Color fundus image; image size 2352x1568:
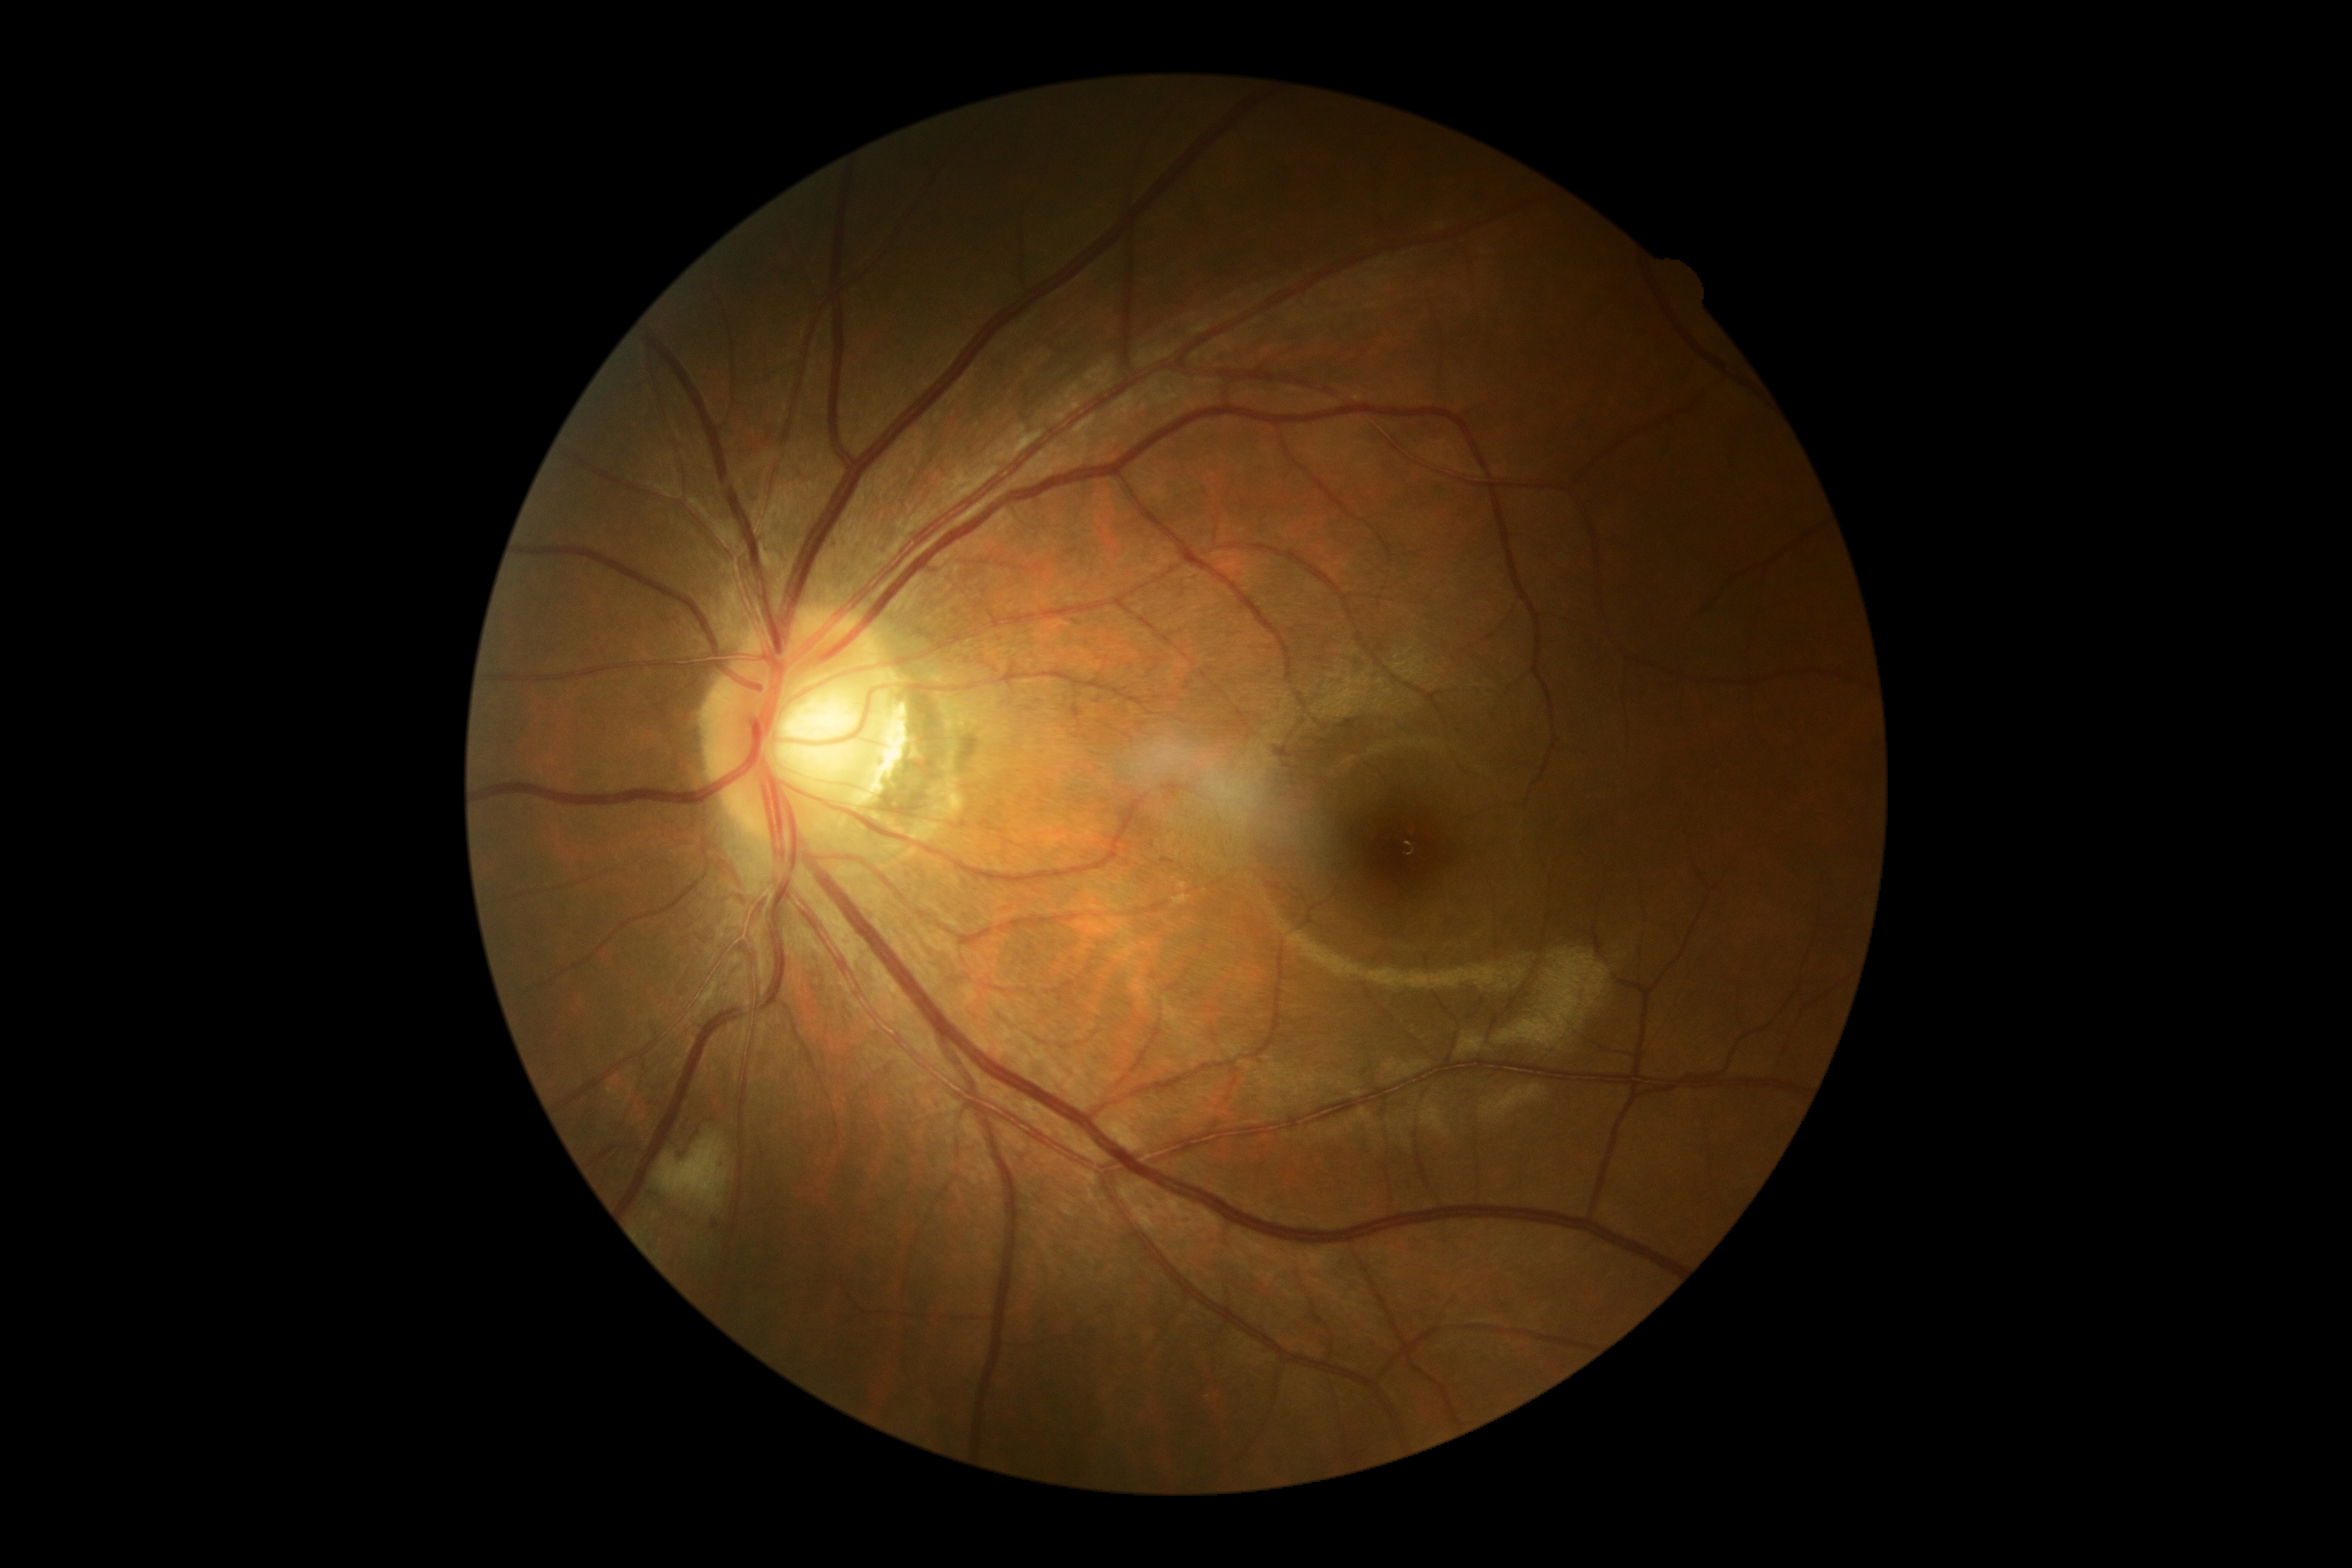
The retinopathy is classified as non-proliferative diabetic retinopathy.
Diabetic retinopathy (DR): grade 2.